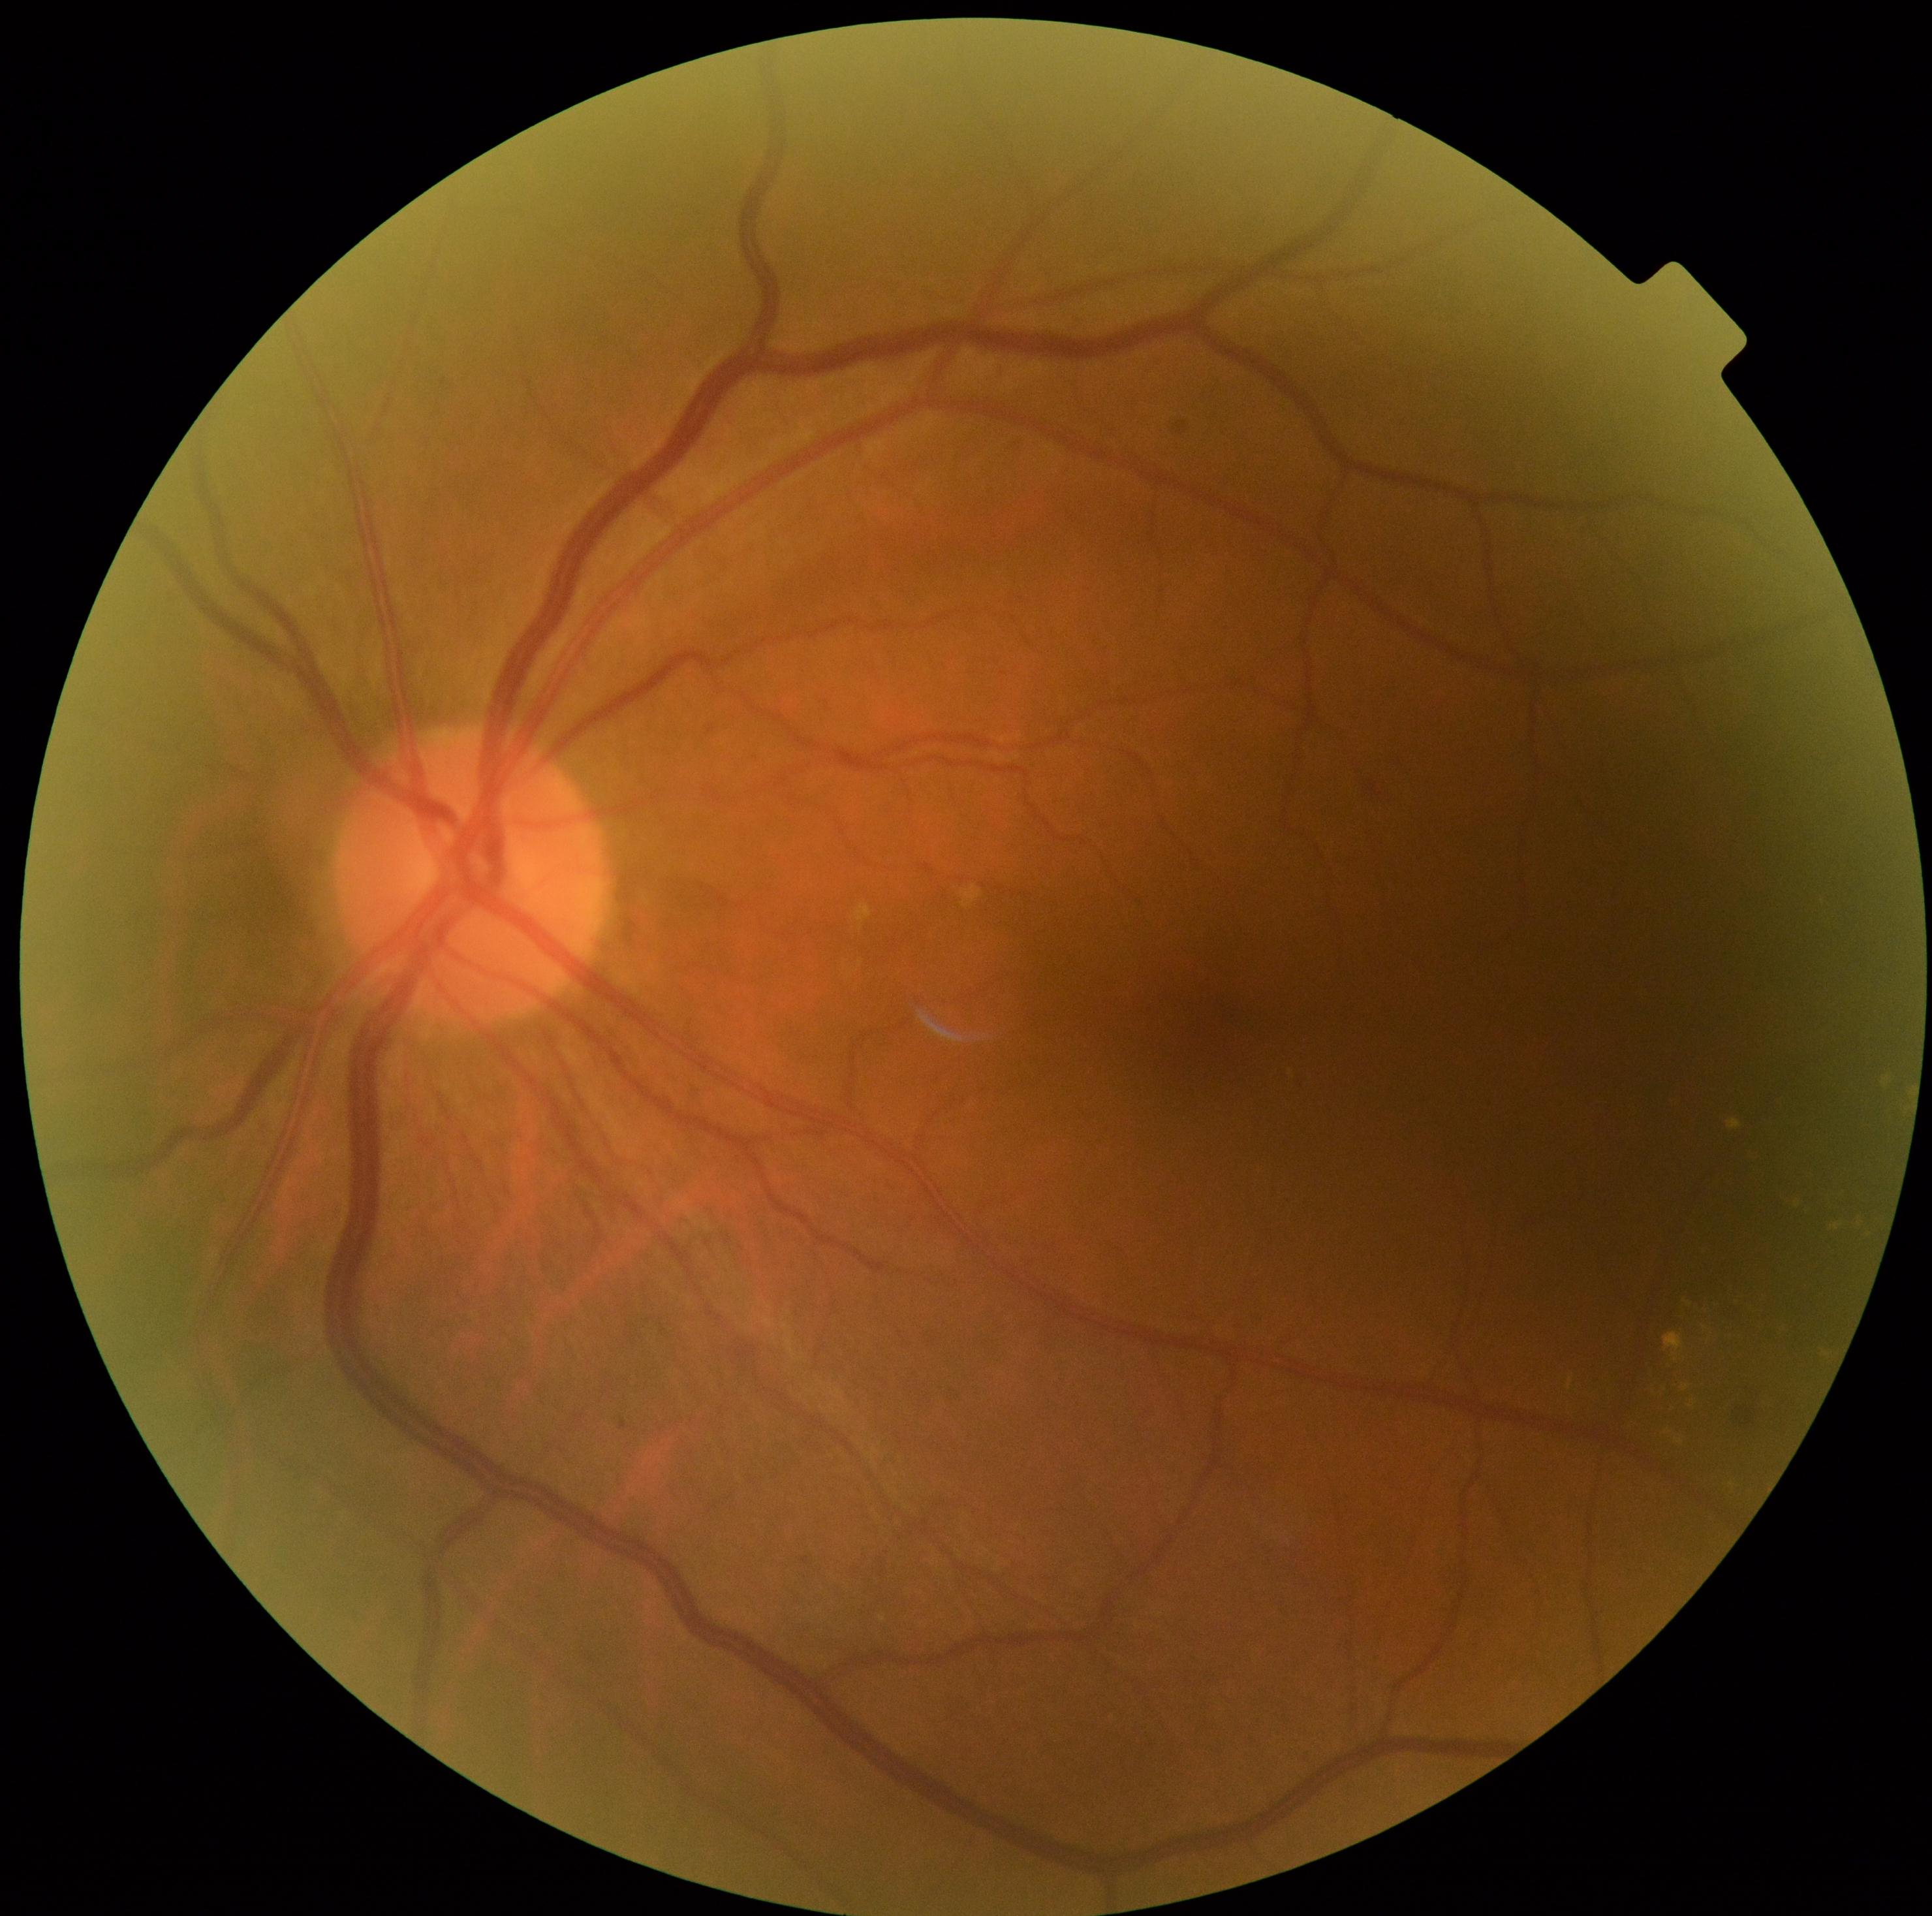

diabetic retinopathy severity=grade 2 (moderate NPDR).